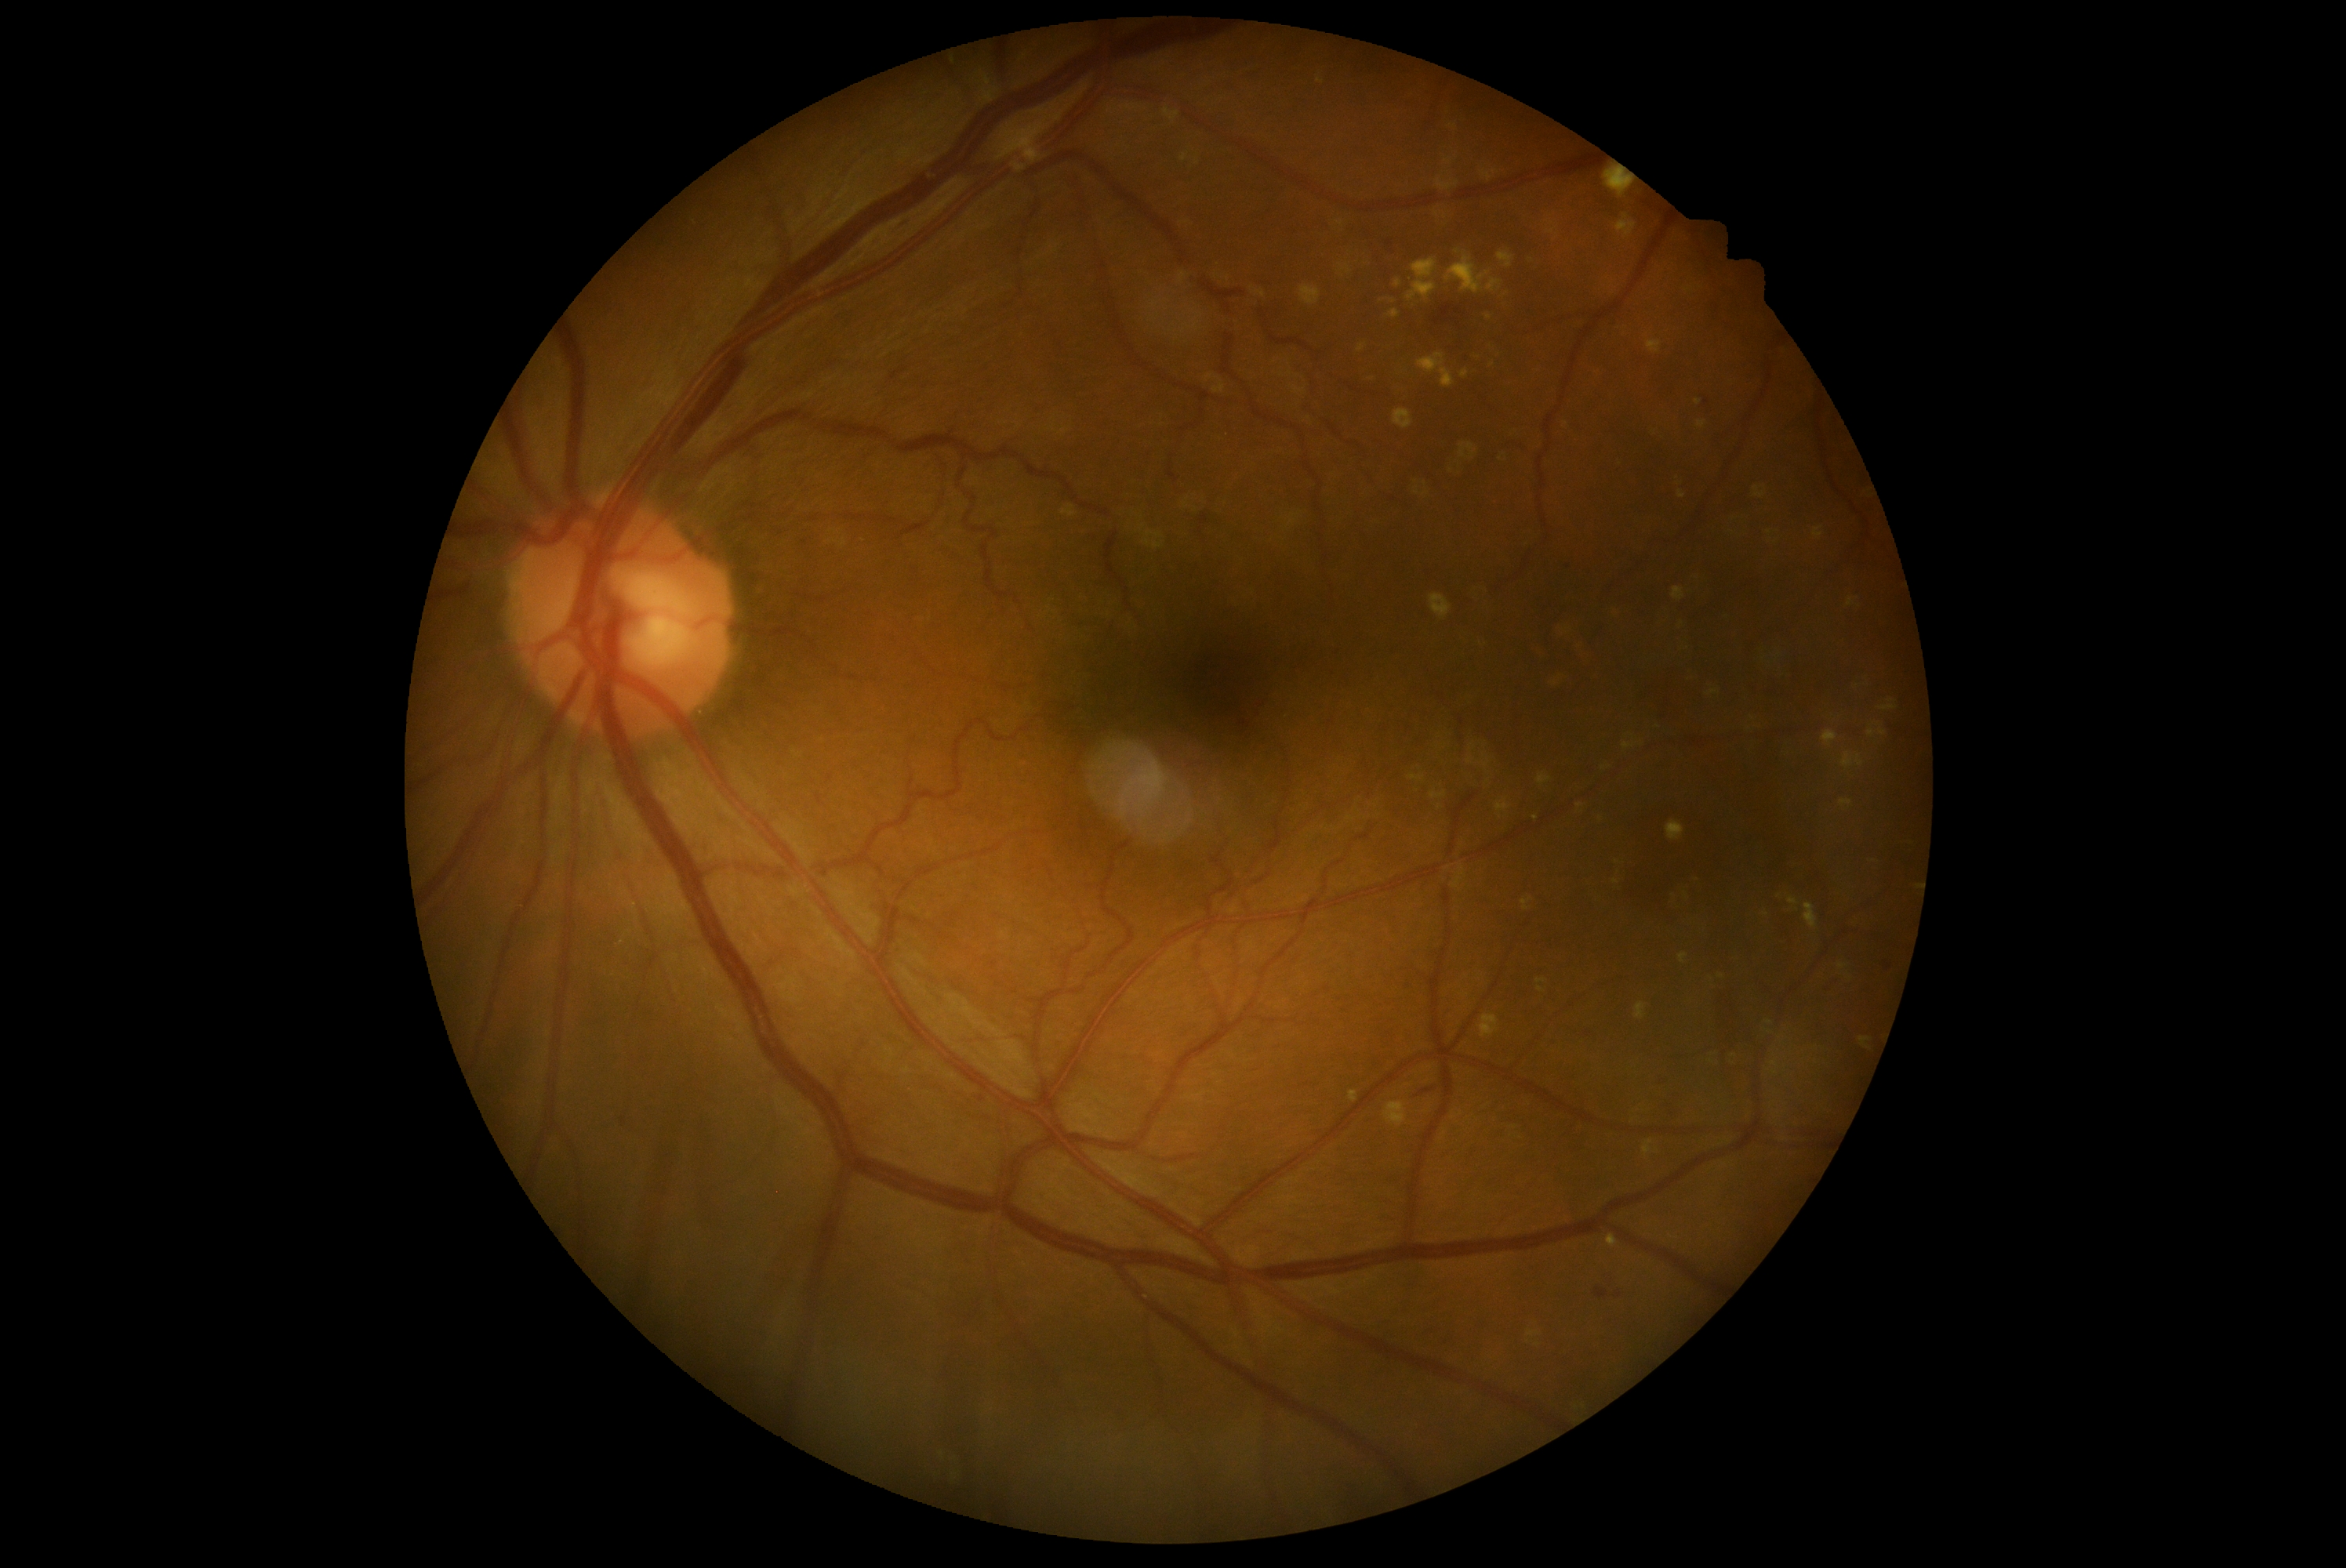
Disease class: non-proliferative diabetic retinopathy. Retinopathy grade: moderate NPDR (2).